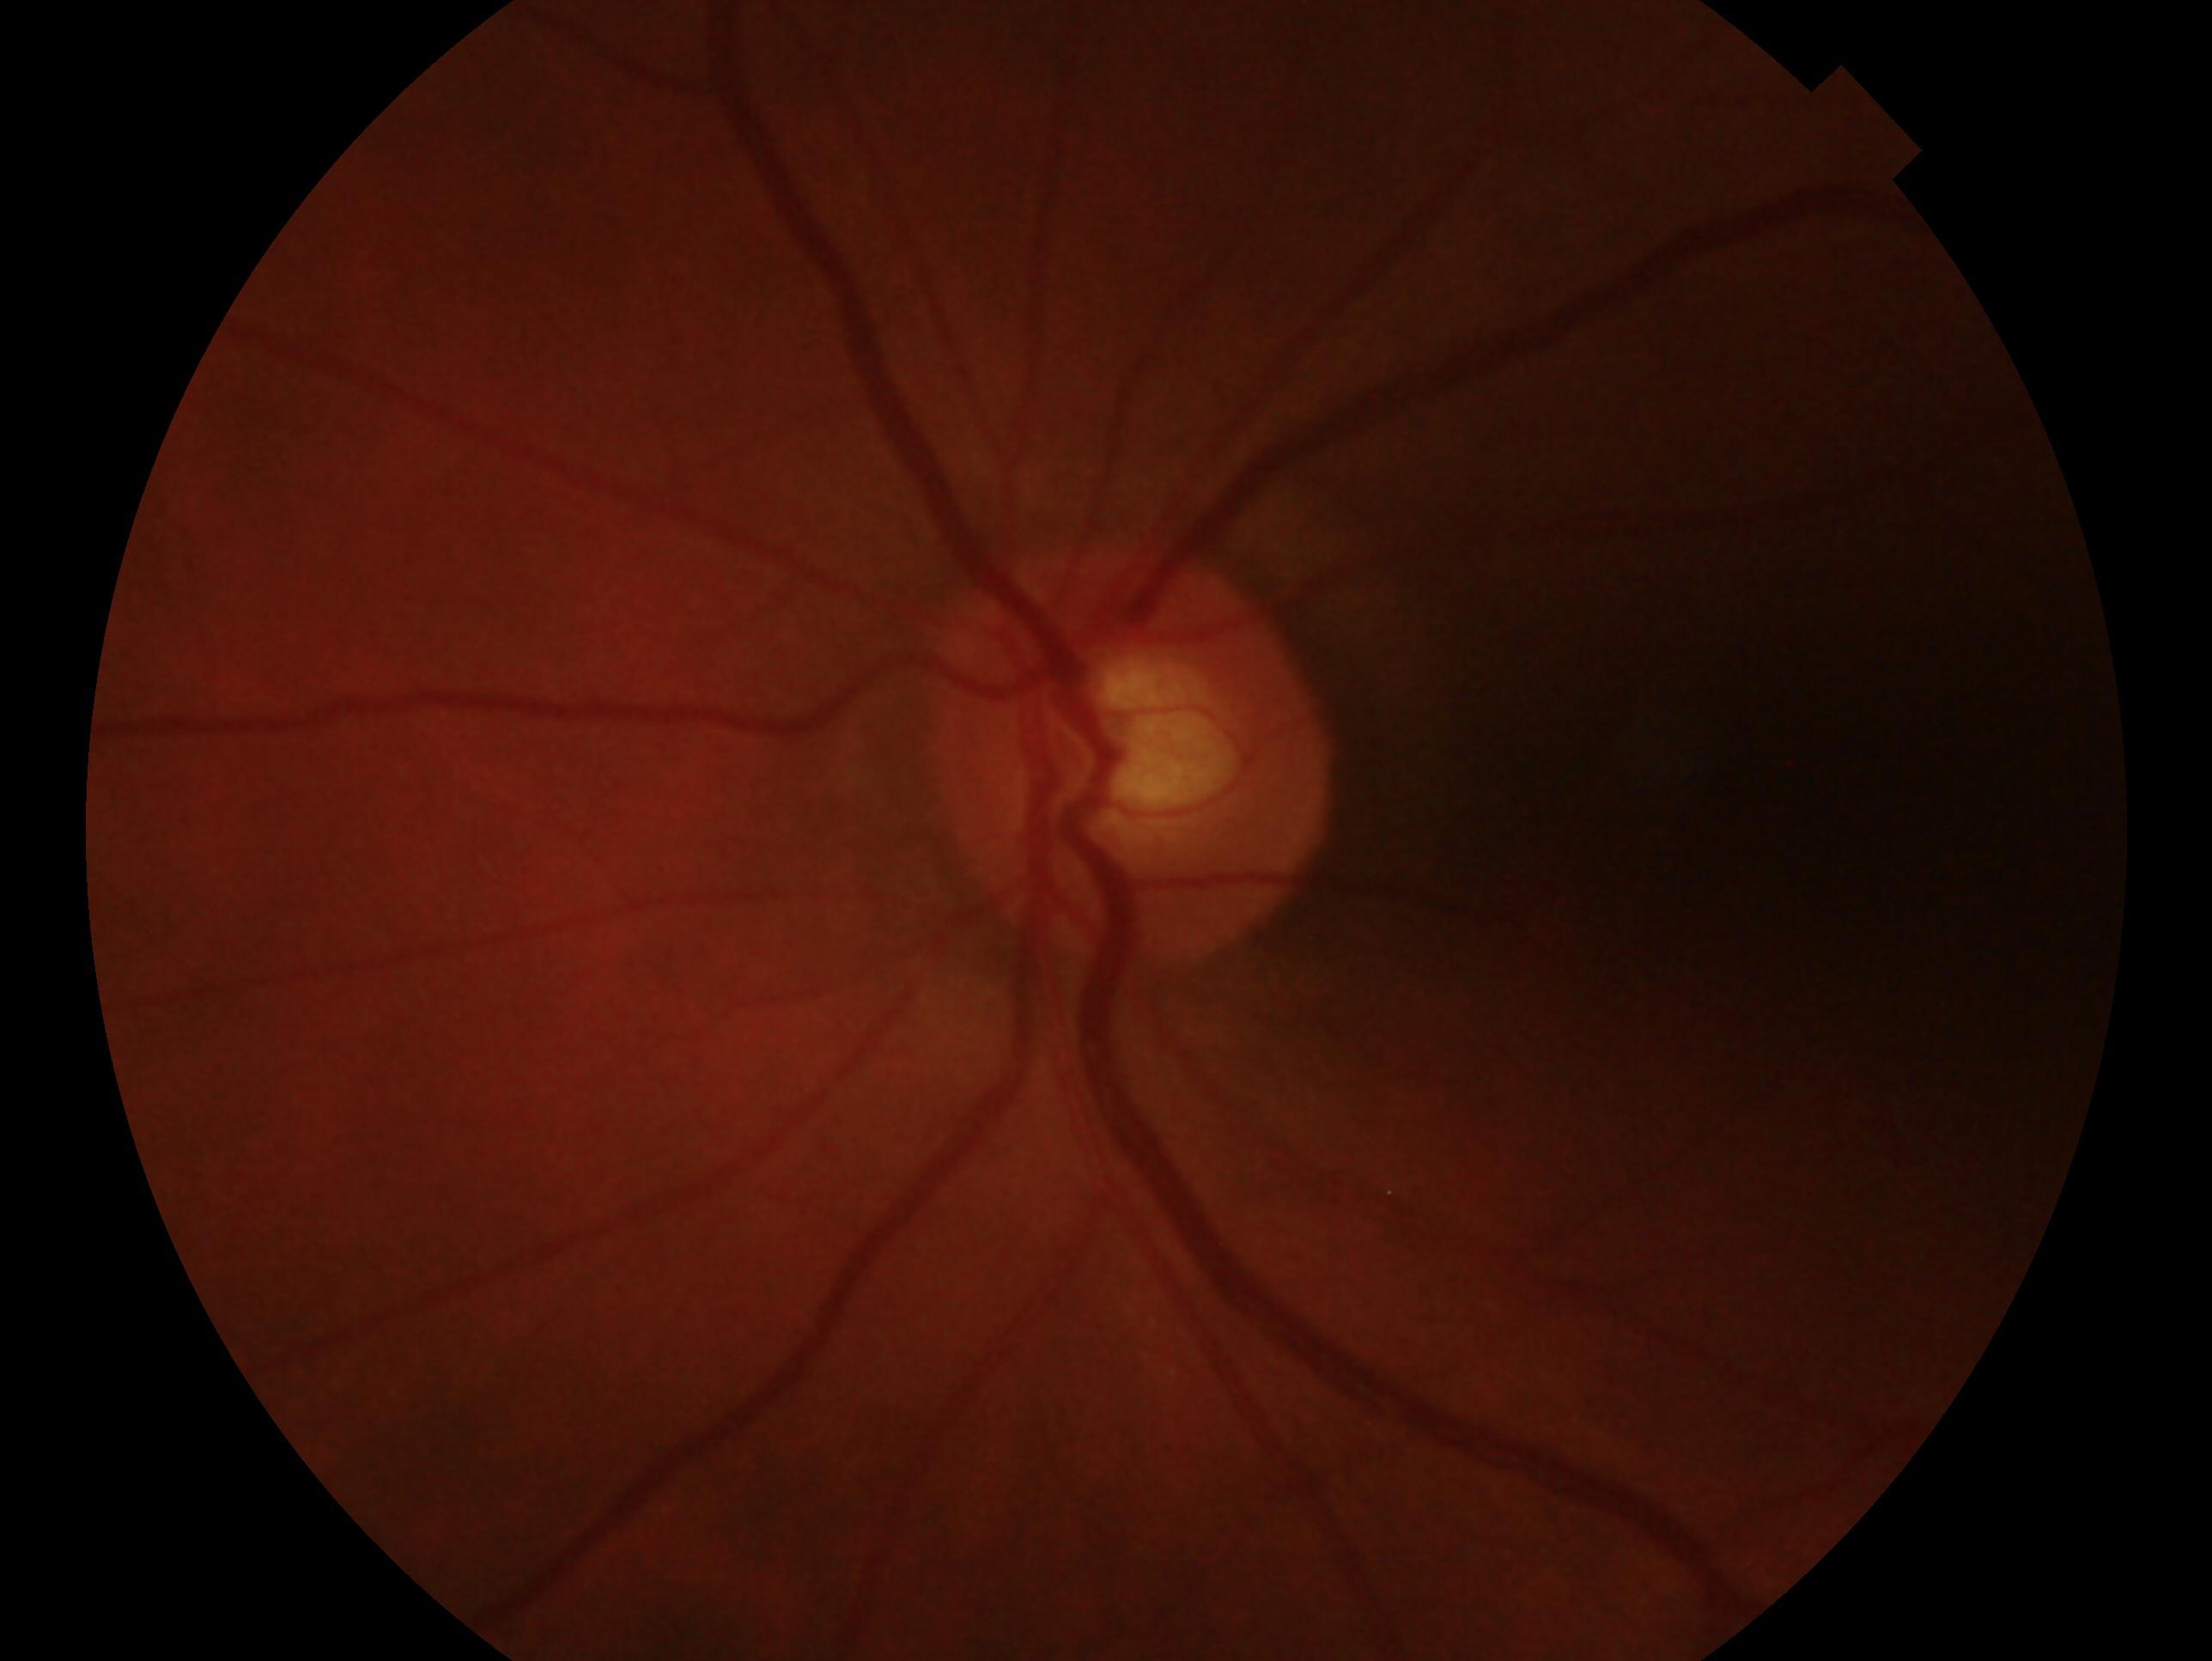 Glaucoma assessment: no signs of glaucoma. This is the OS.